CFP — 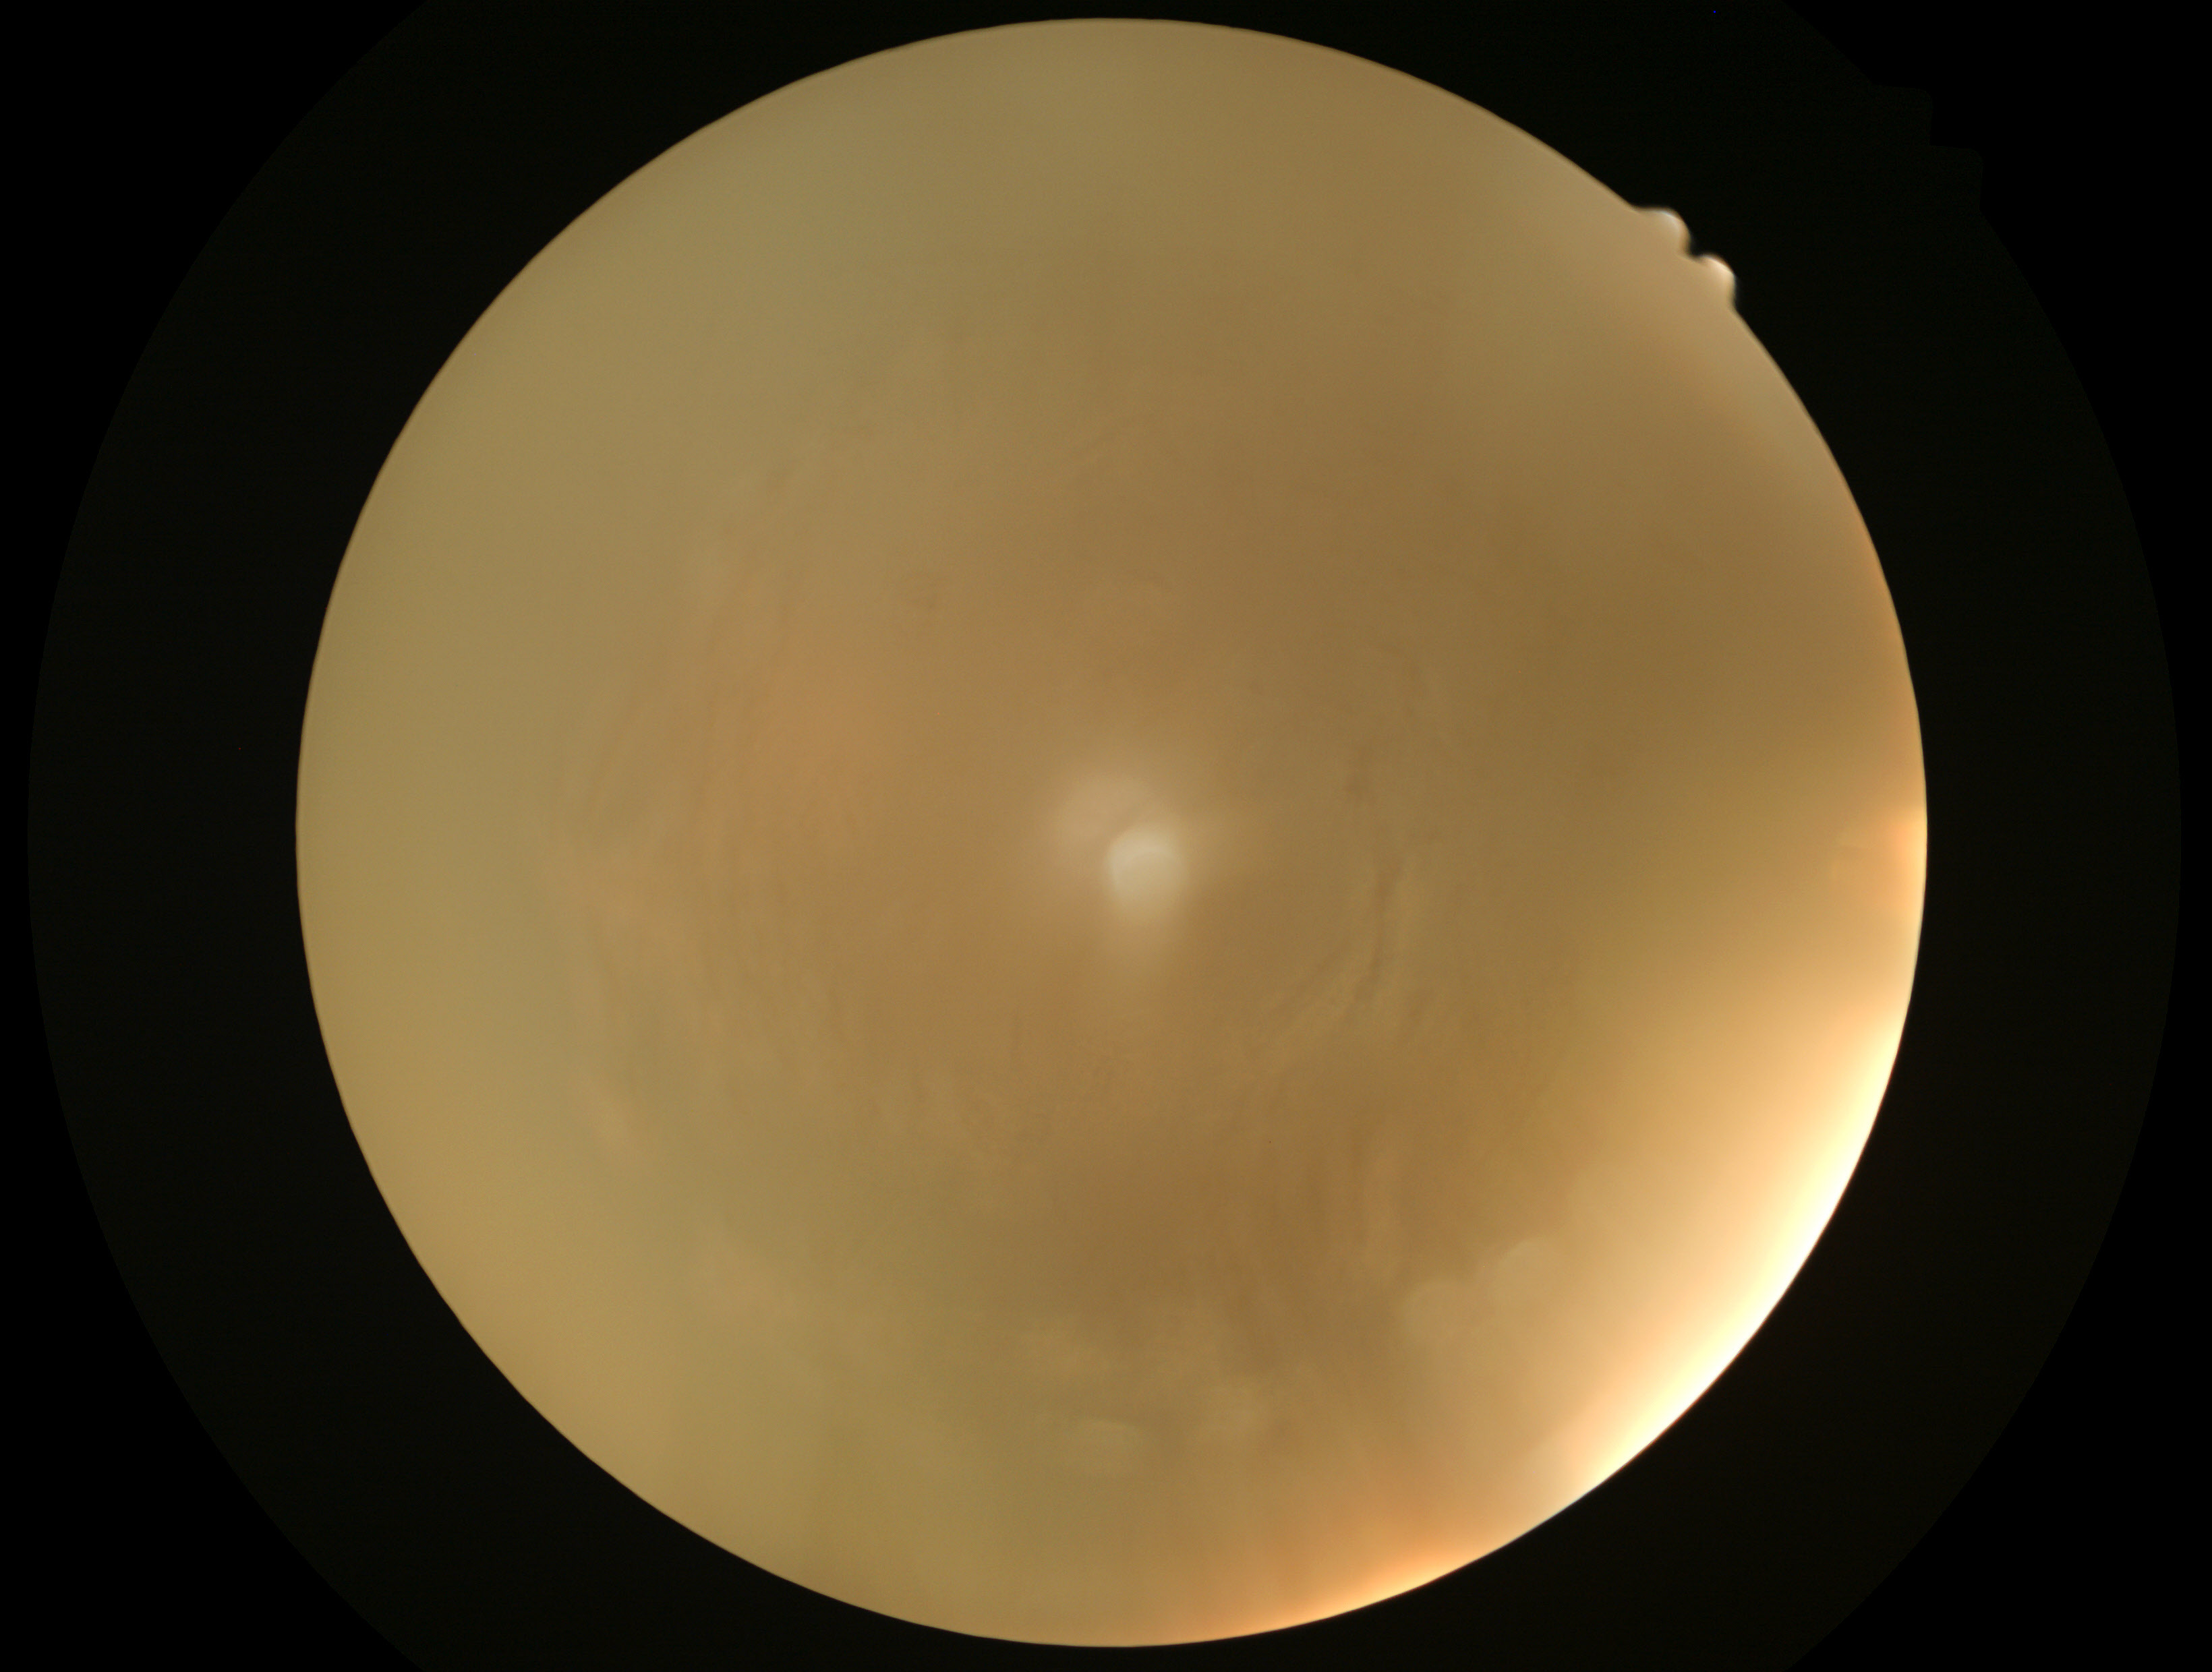
retinopathy: ungradable due to poor image quality